2212 by 1659 pixels. Color fundus photograph: 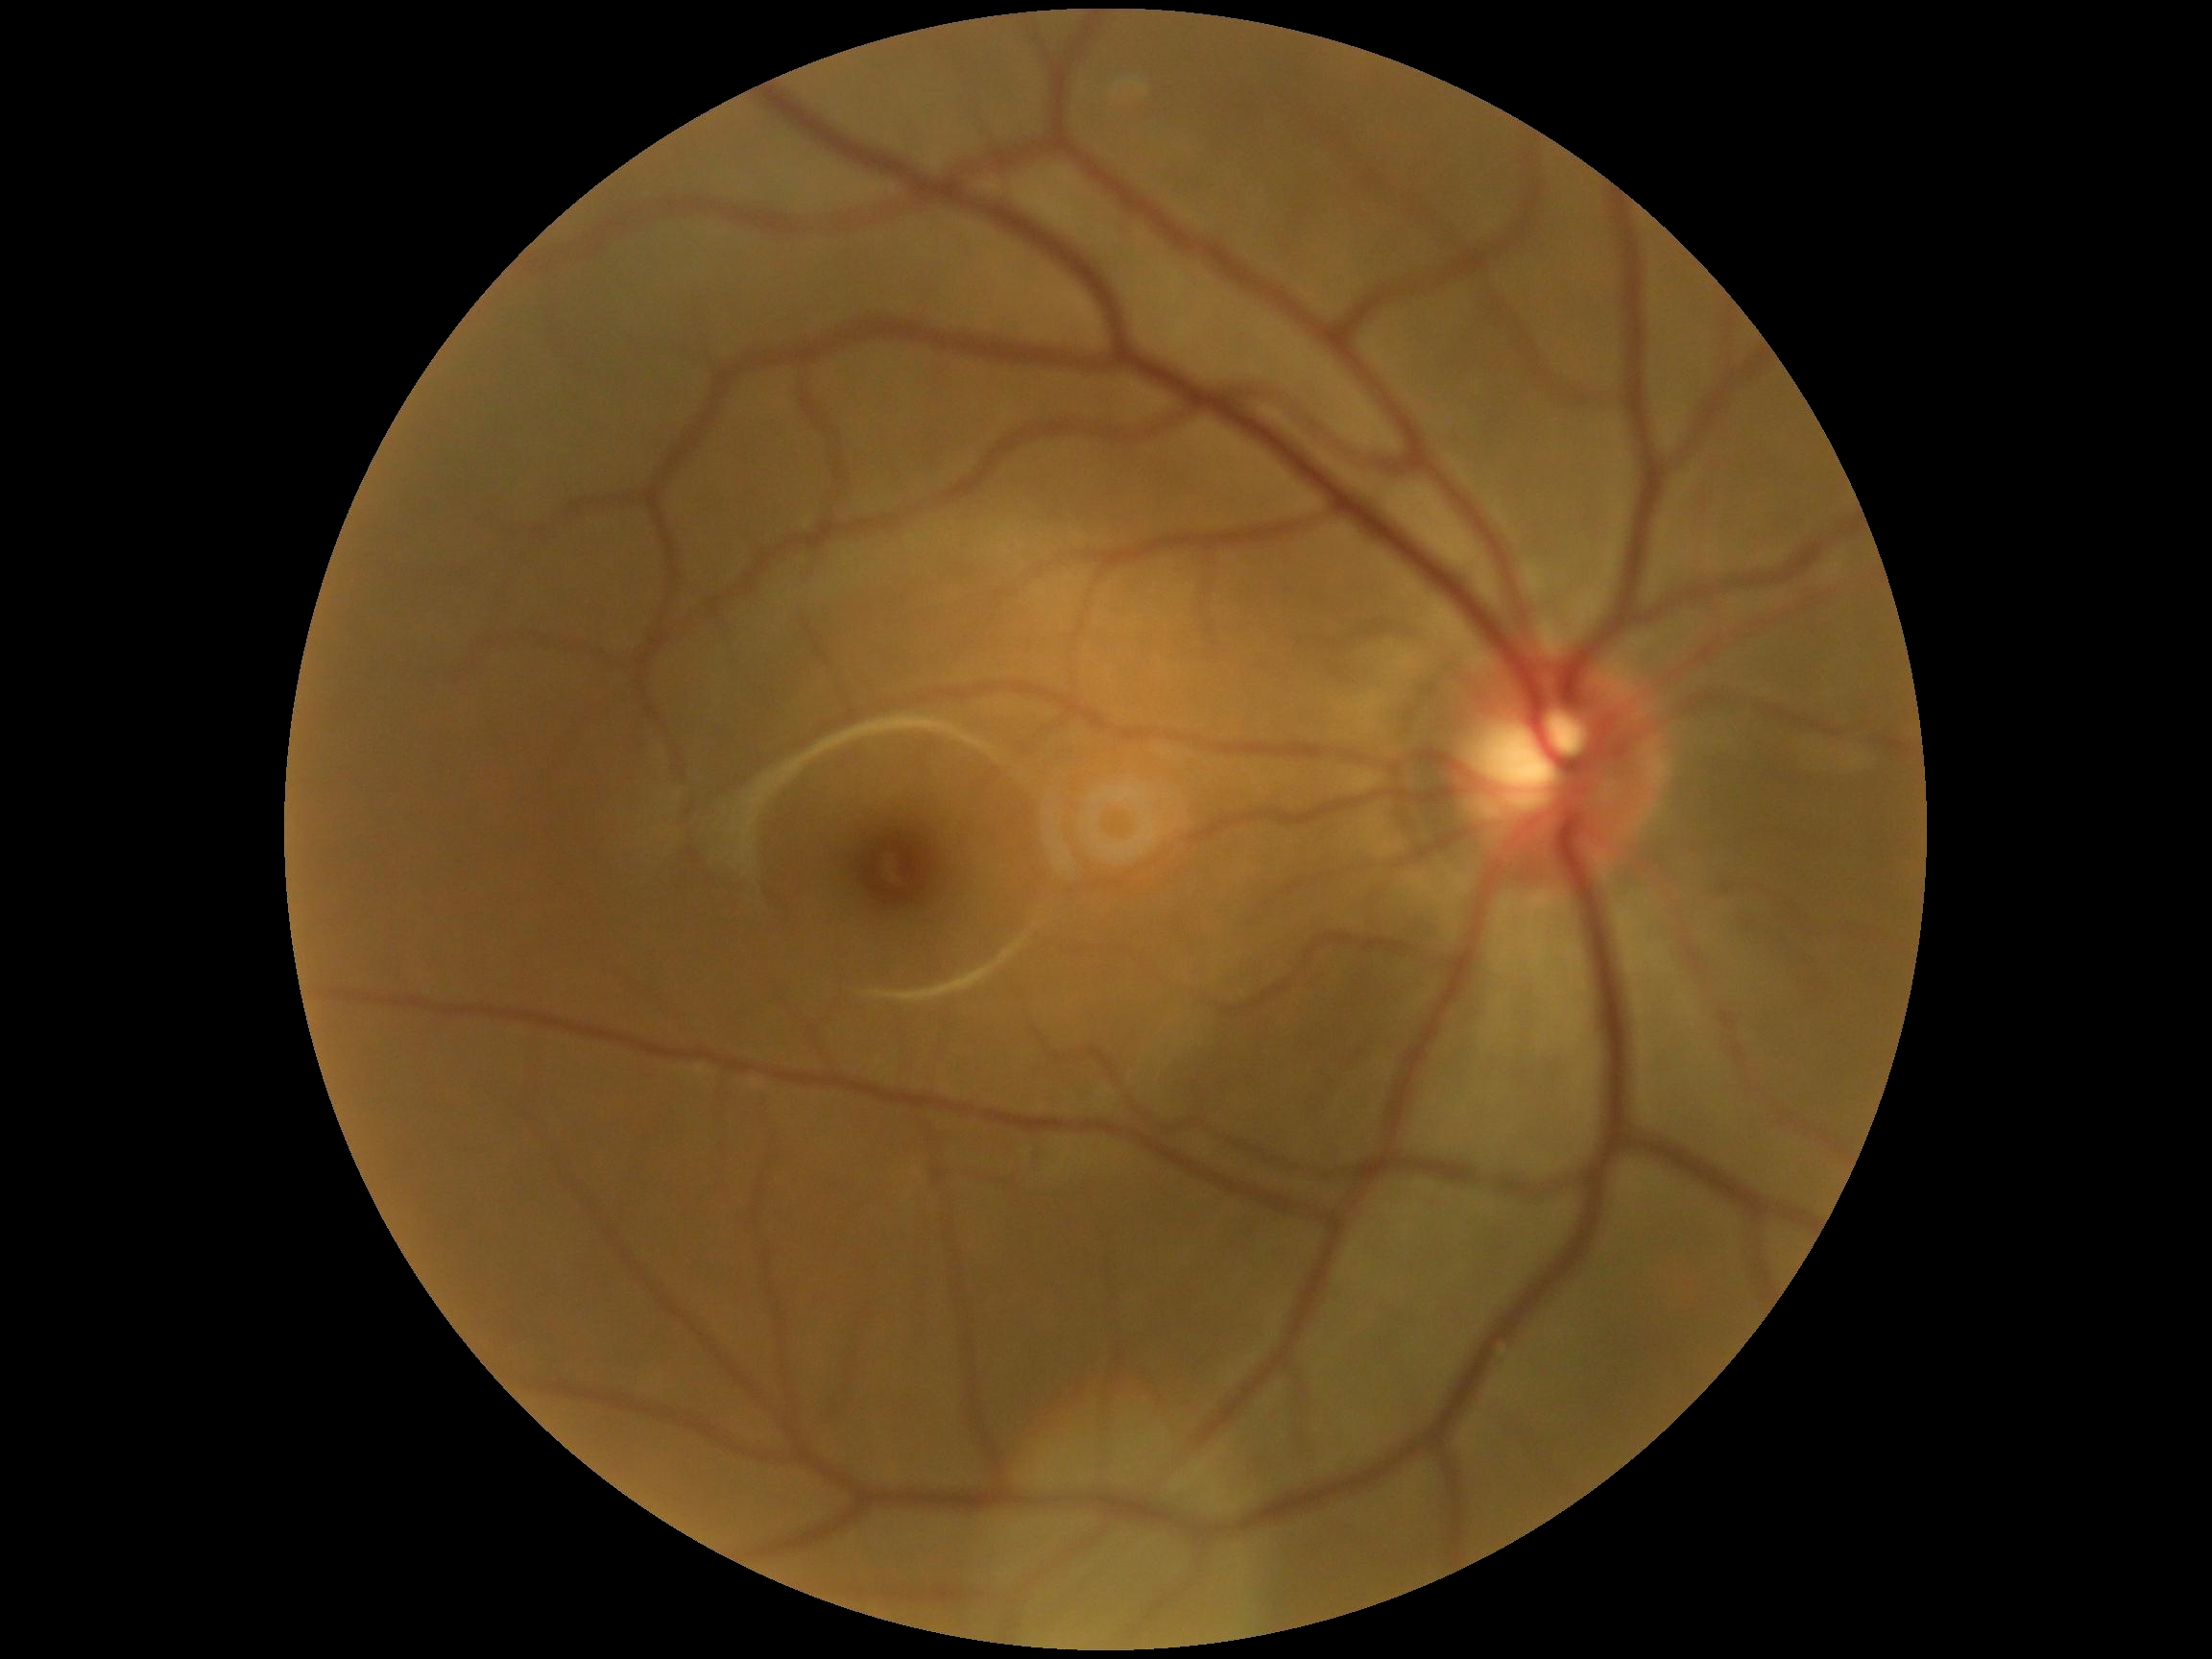

diabetic retinopathy severity@grade 0 — no visible signs of diabetic retinopathy.